130° field of view (Clarity RetCam 3) · wide-field fundus photograph of an infant.
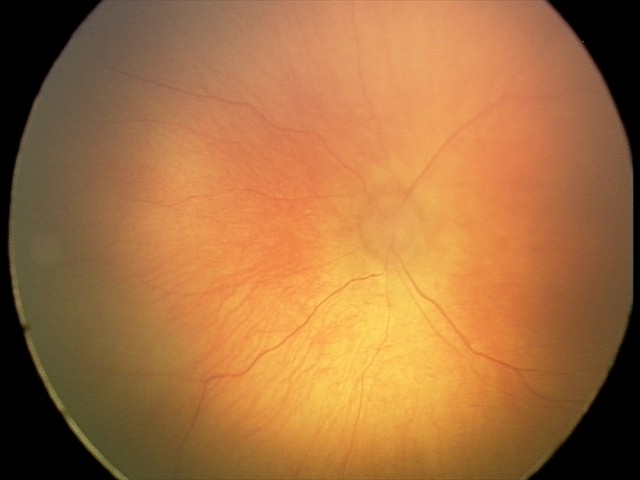
Q: What is the diagnosis from this examination?
A: retinopathy of prematurity stage 0